Image size 2352x1568, CFP, 45° field of view: 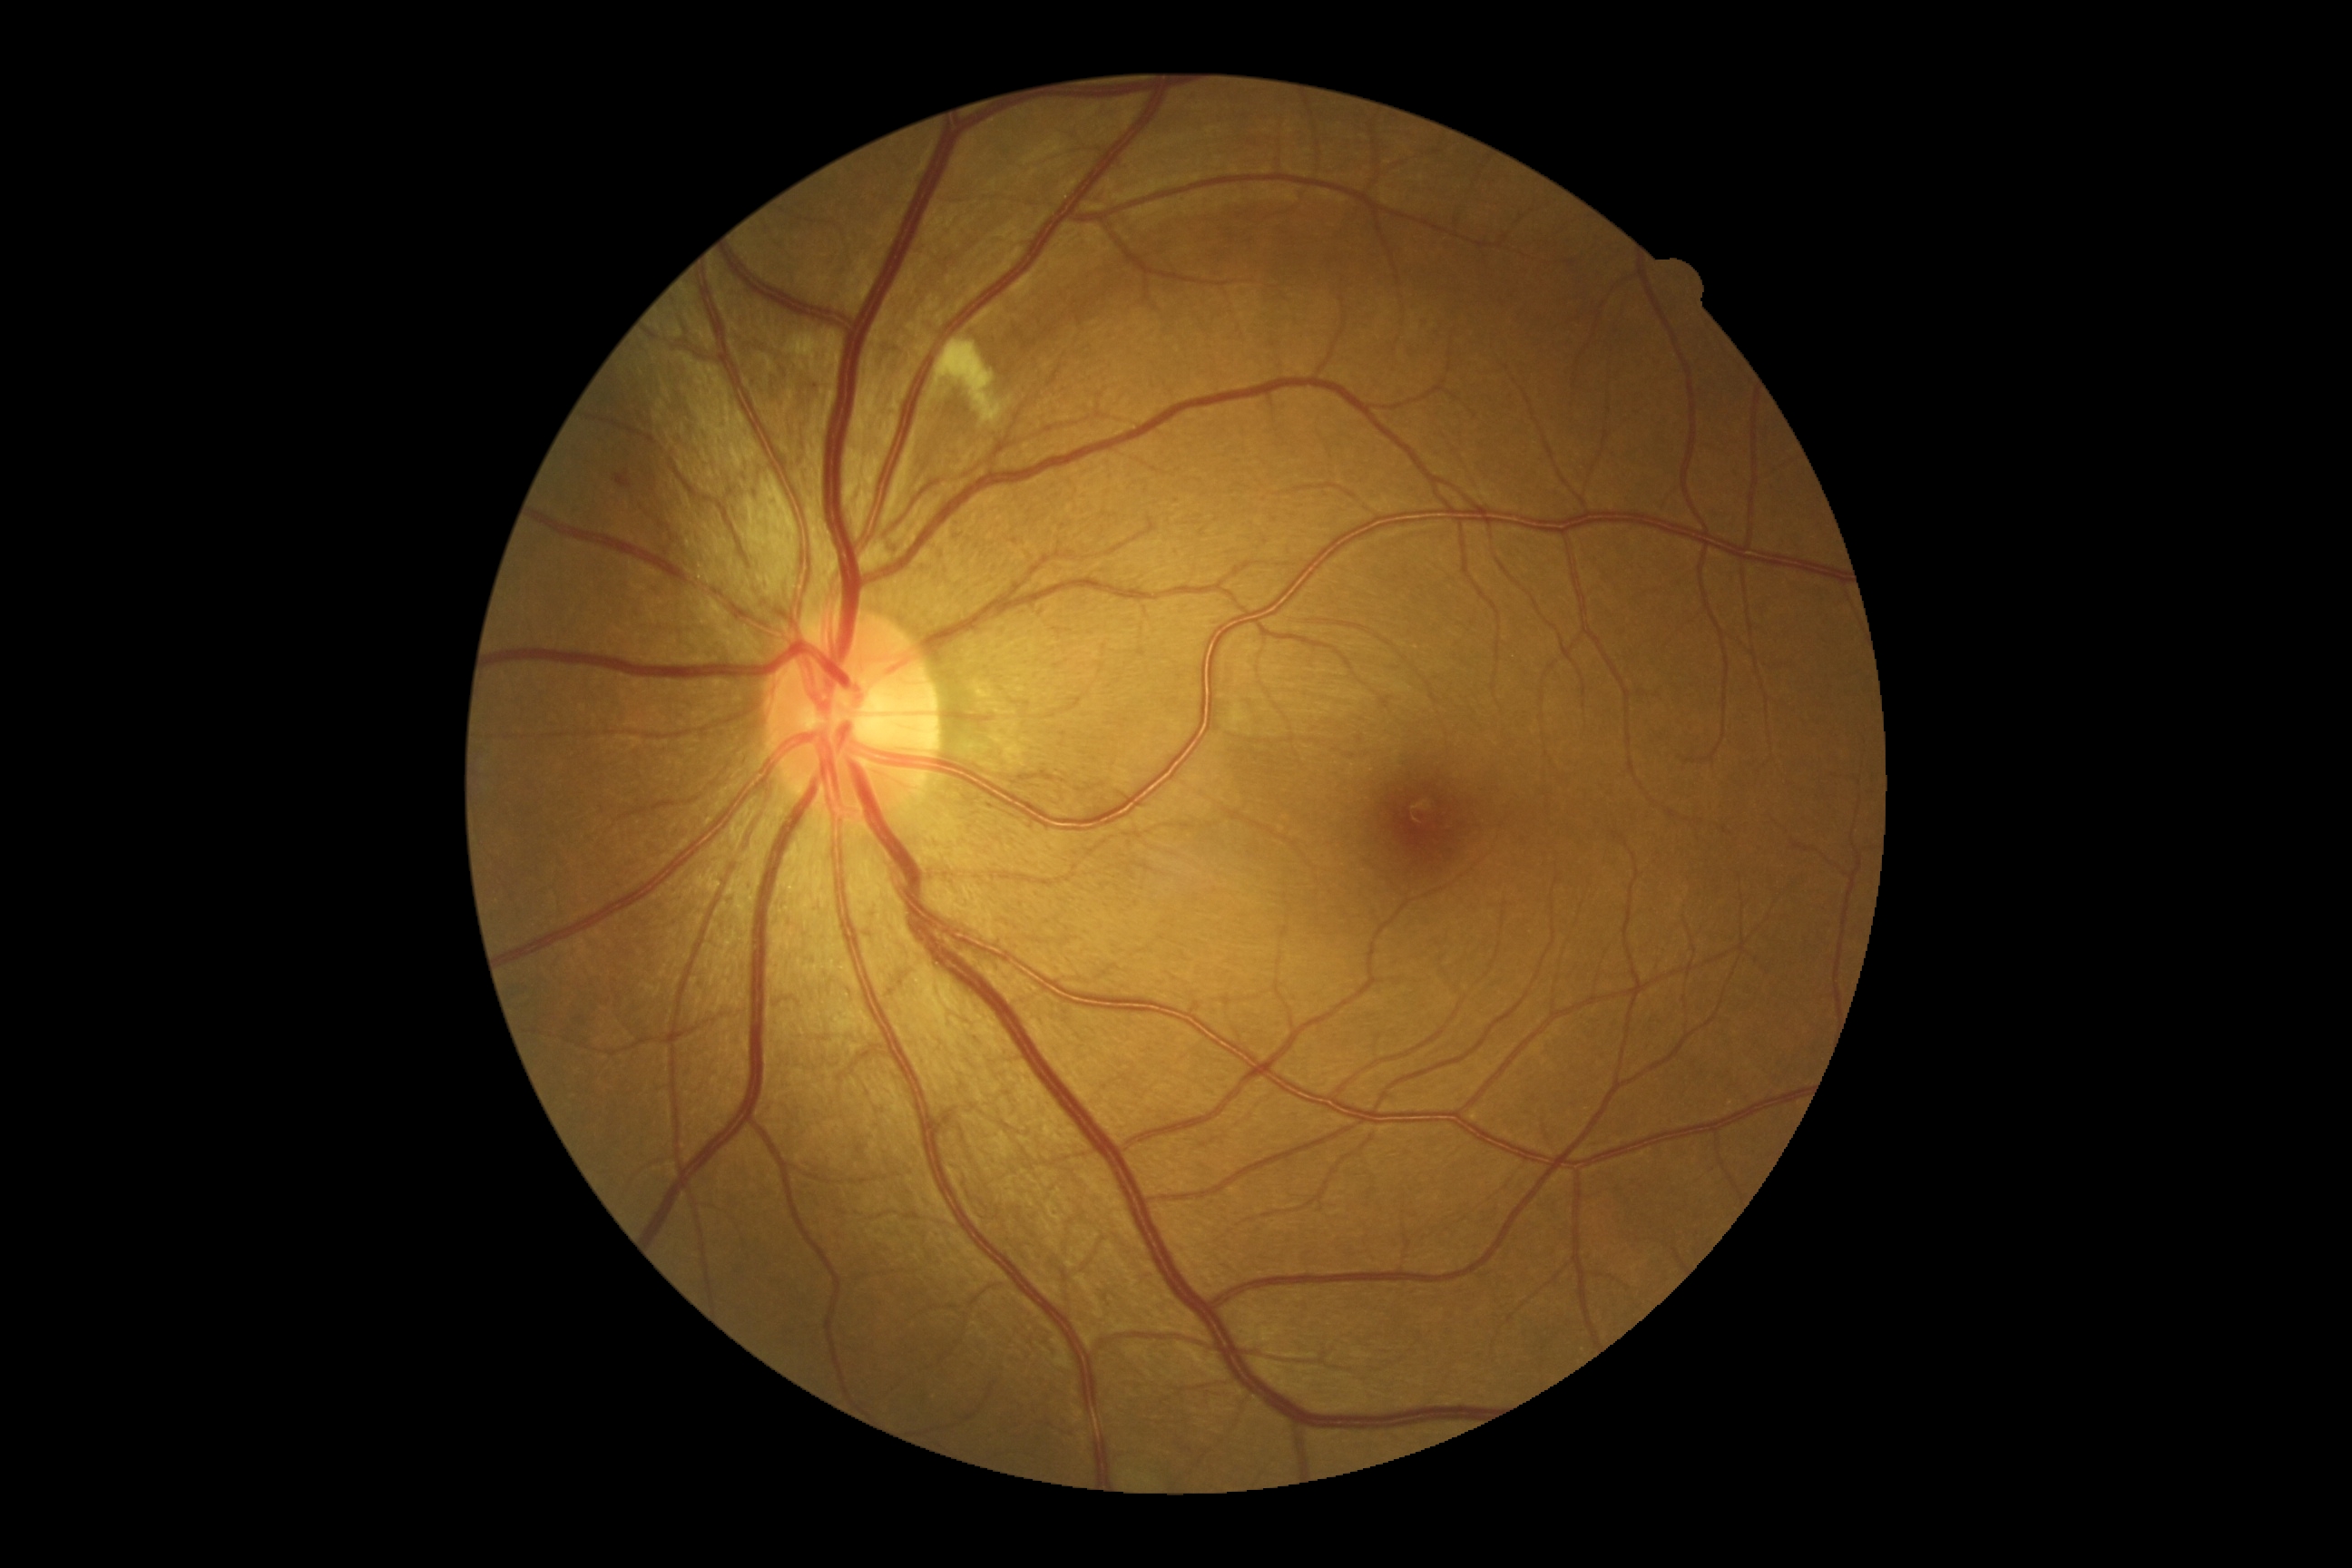 DR severity@2.